2352 by 1568 pixels.
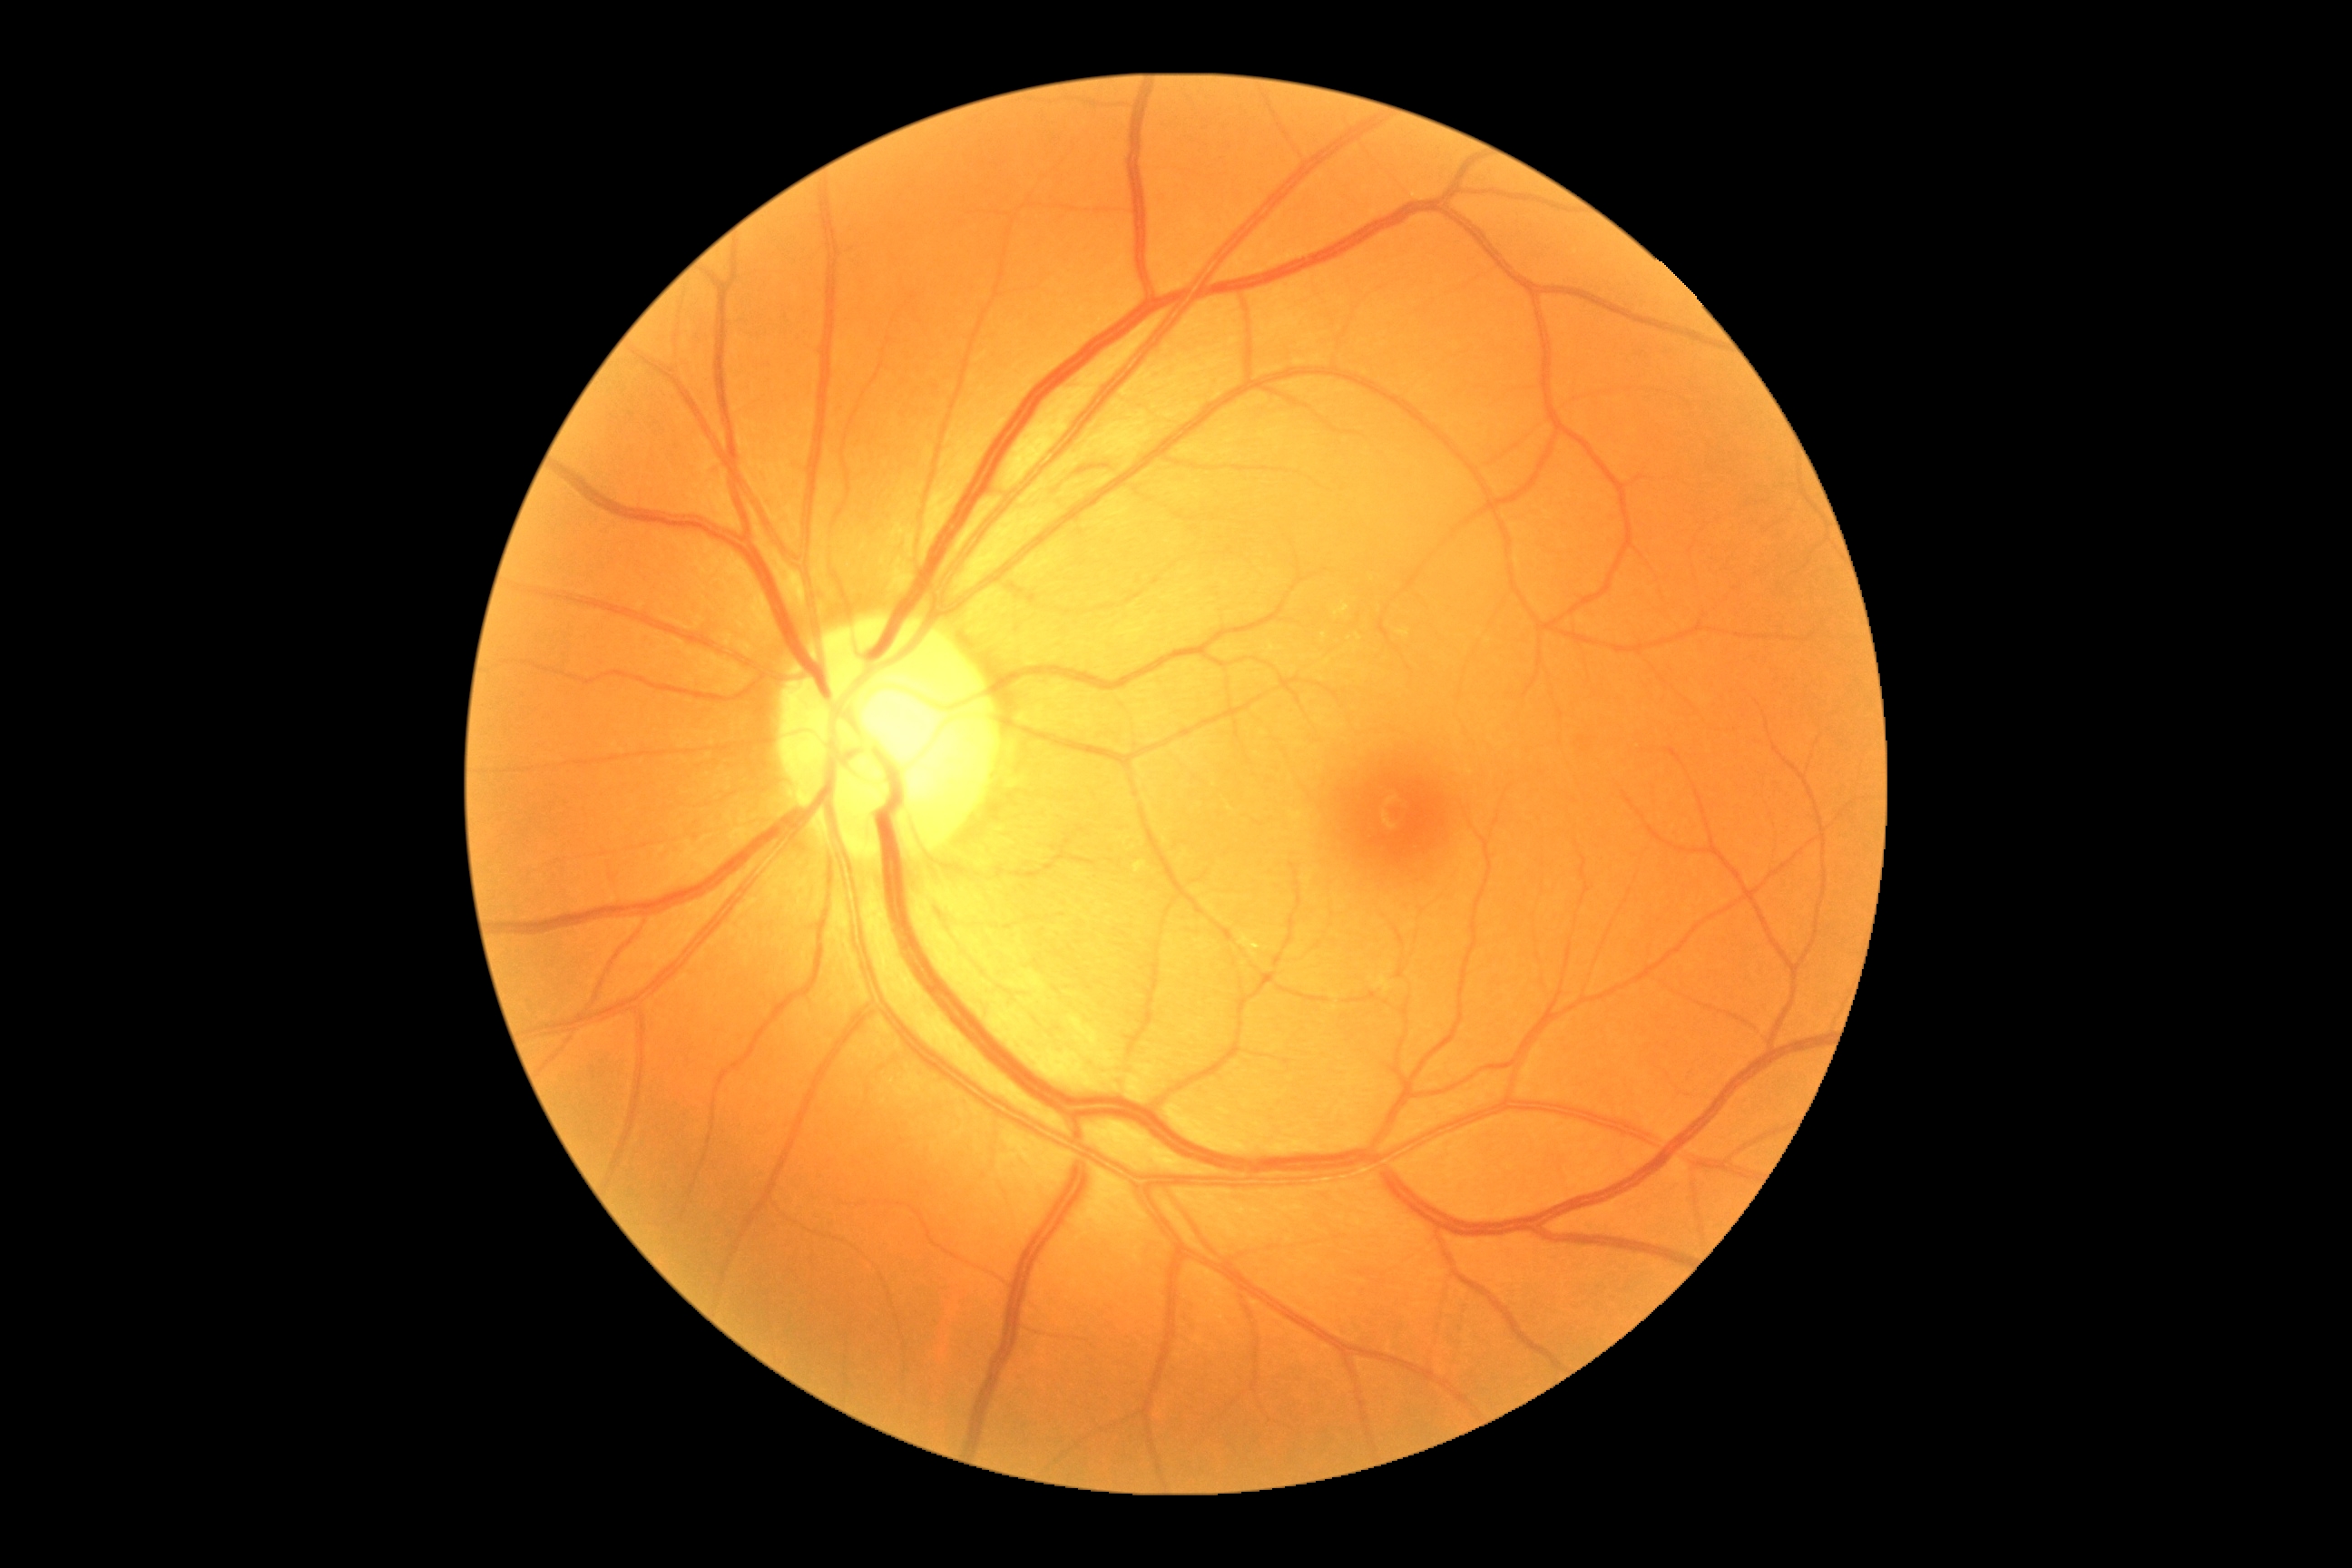

Diabetic retinopathy (DR) is 0/4 — no visible signs of diabetic retinopathy.